Acquired on the Clarity RetCam 3; RetCam wide-field infant fundus image — 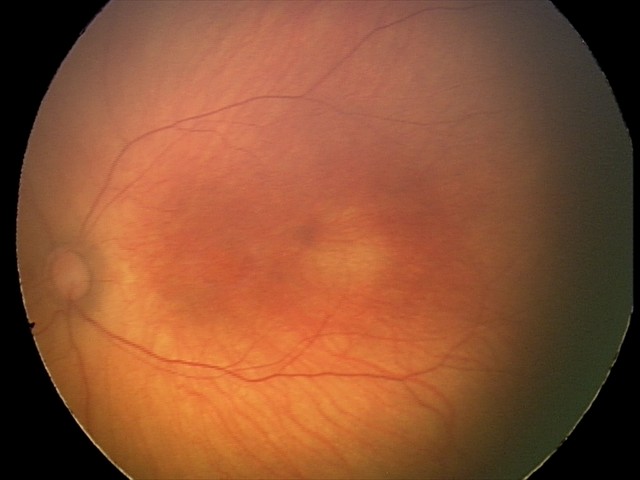

Diagnosis: no pathology identified.